FOV: 45 degrees. 848x848.
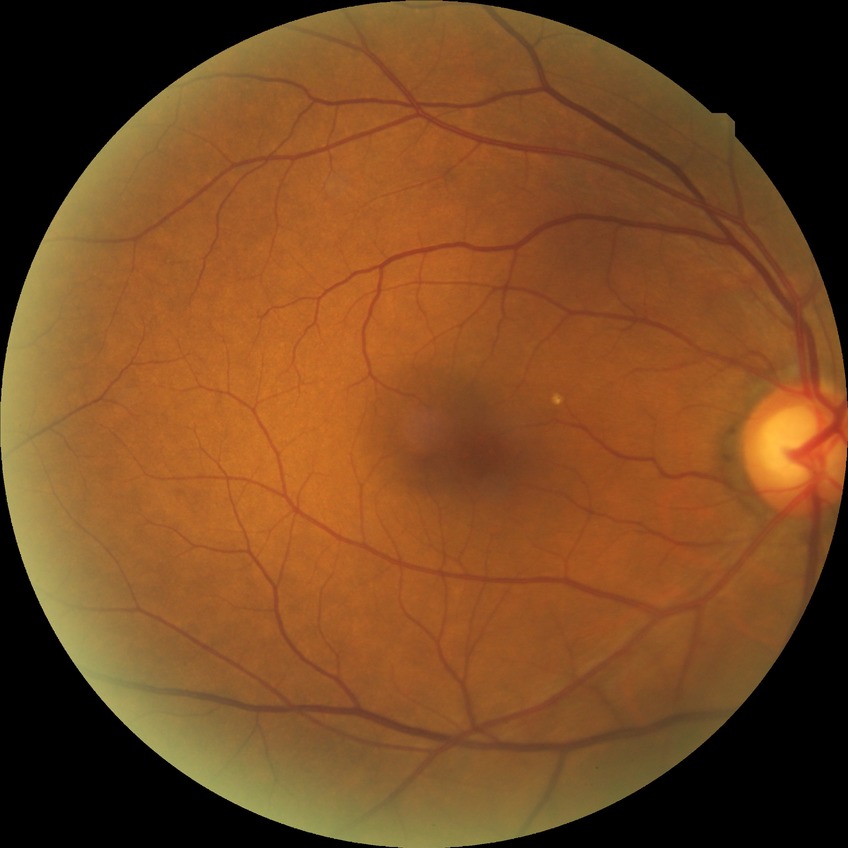
Davis grading: no diabetic retinopathy.